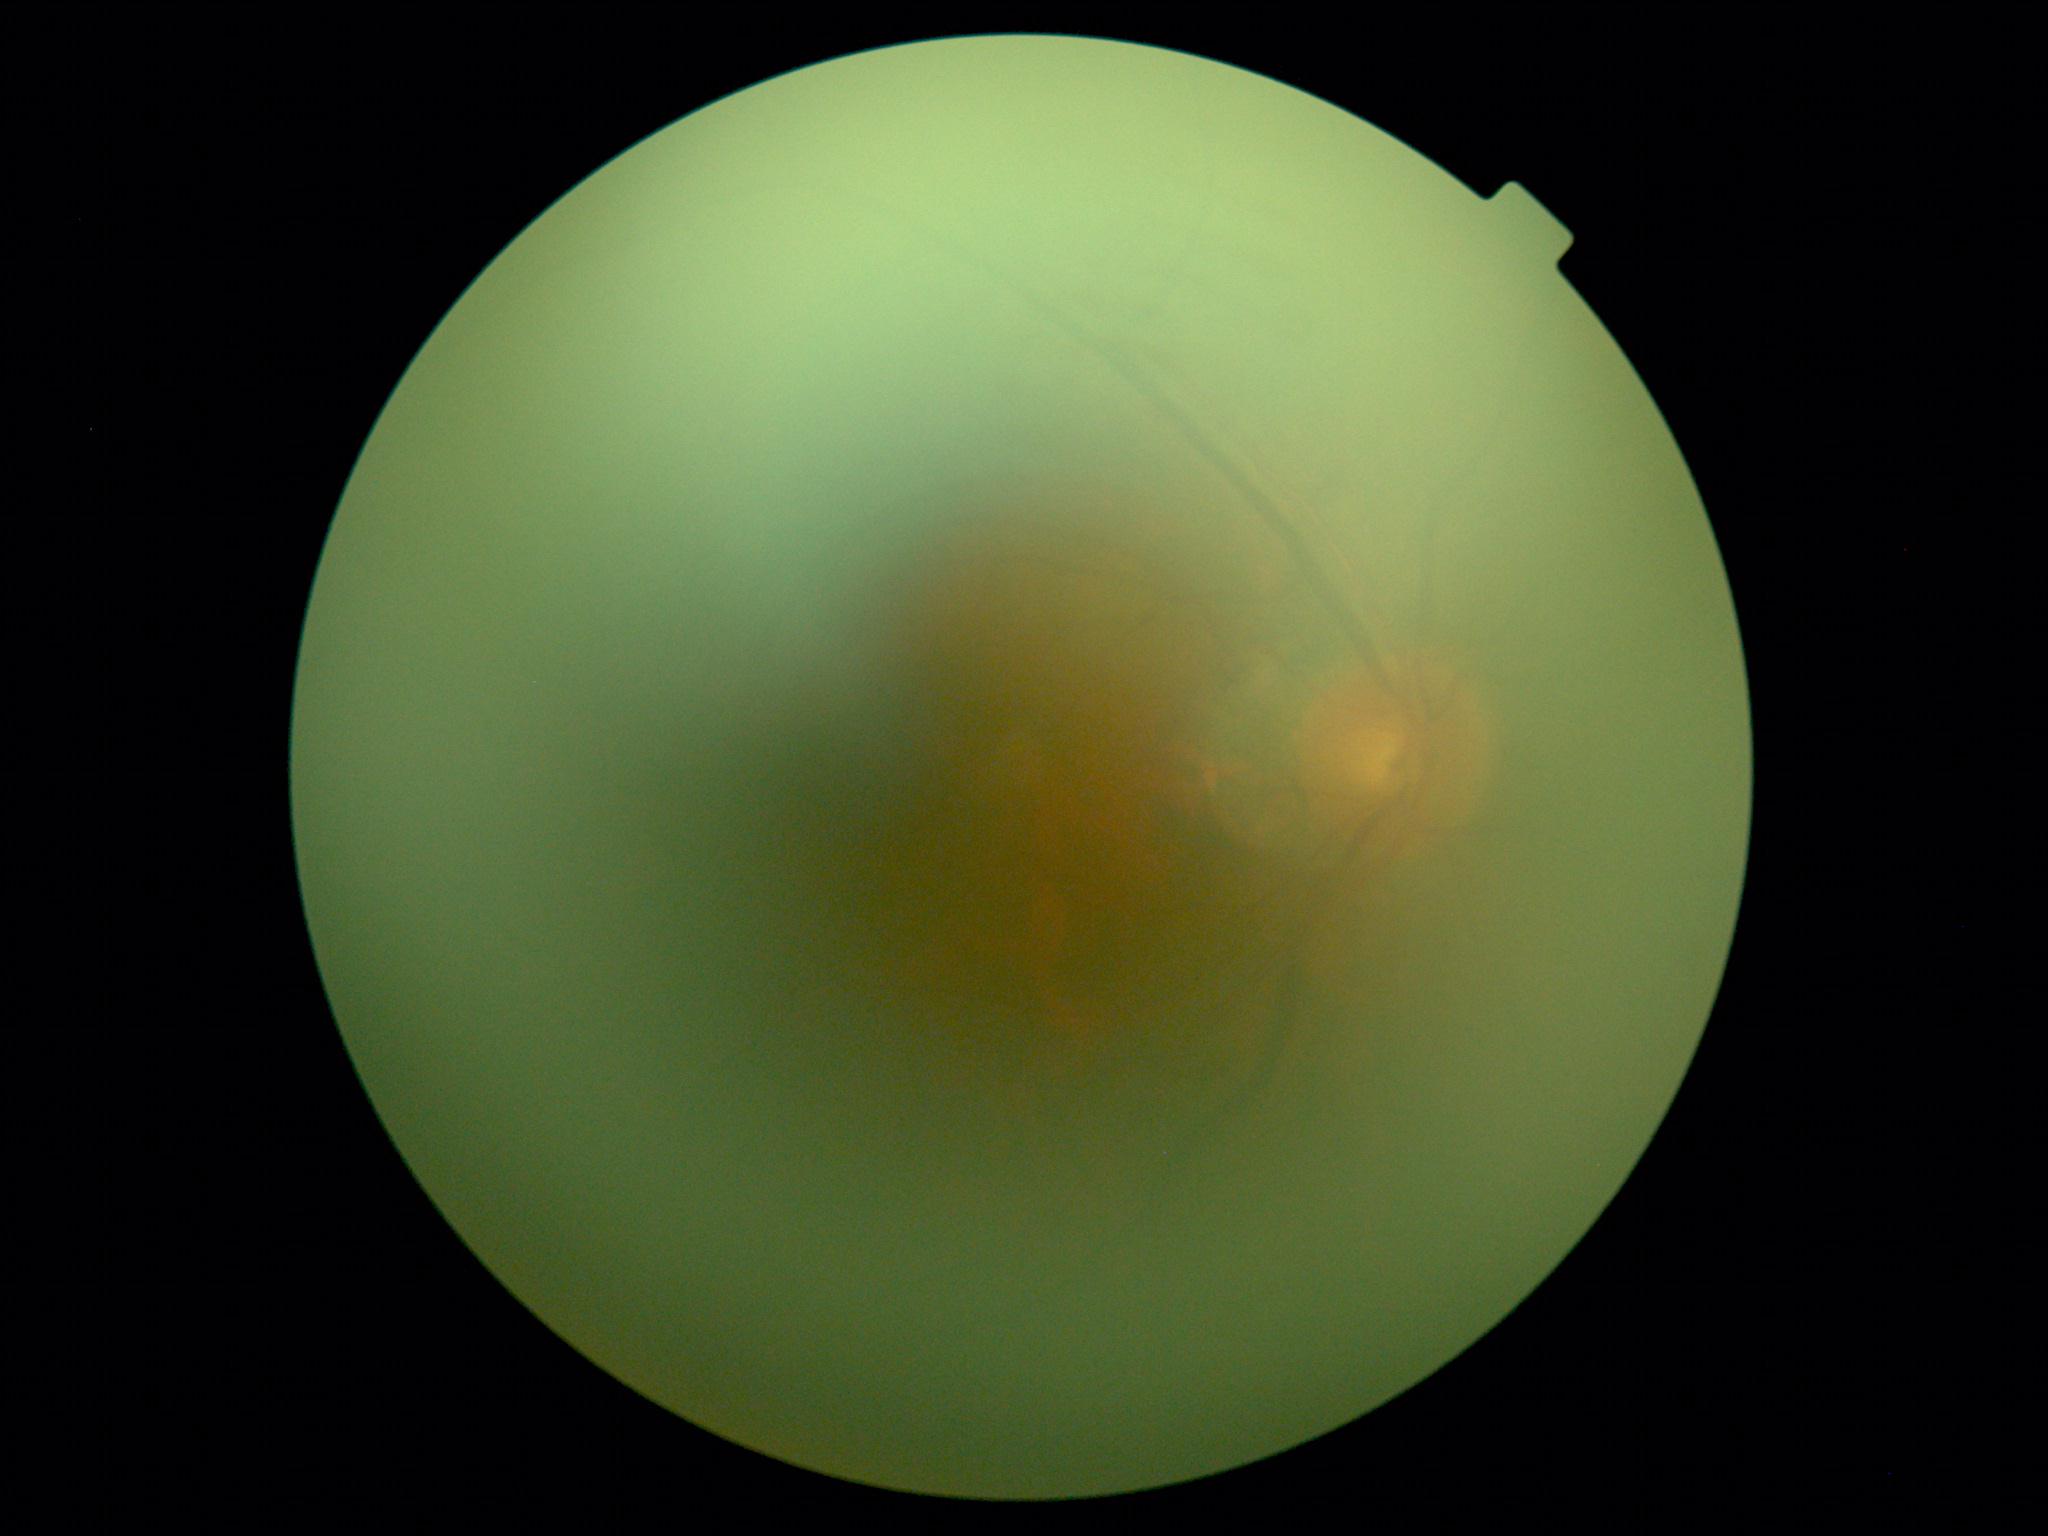
dr_grade: ungradable due to poor image quality